Retinal fundus photograph; image size 2212x1659; 45-degree field of view.
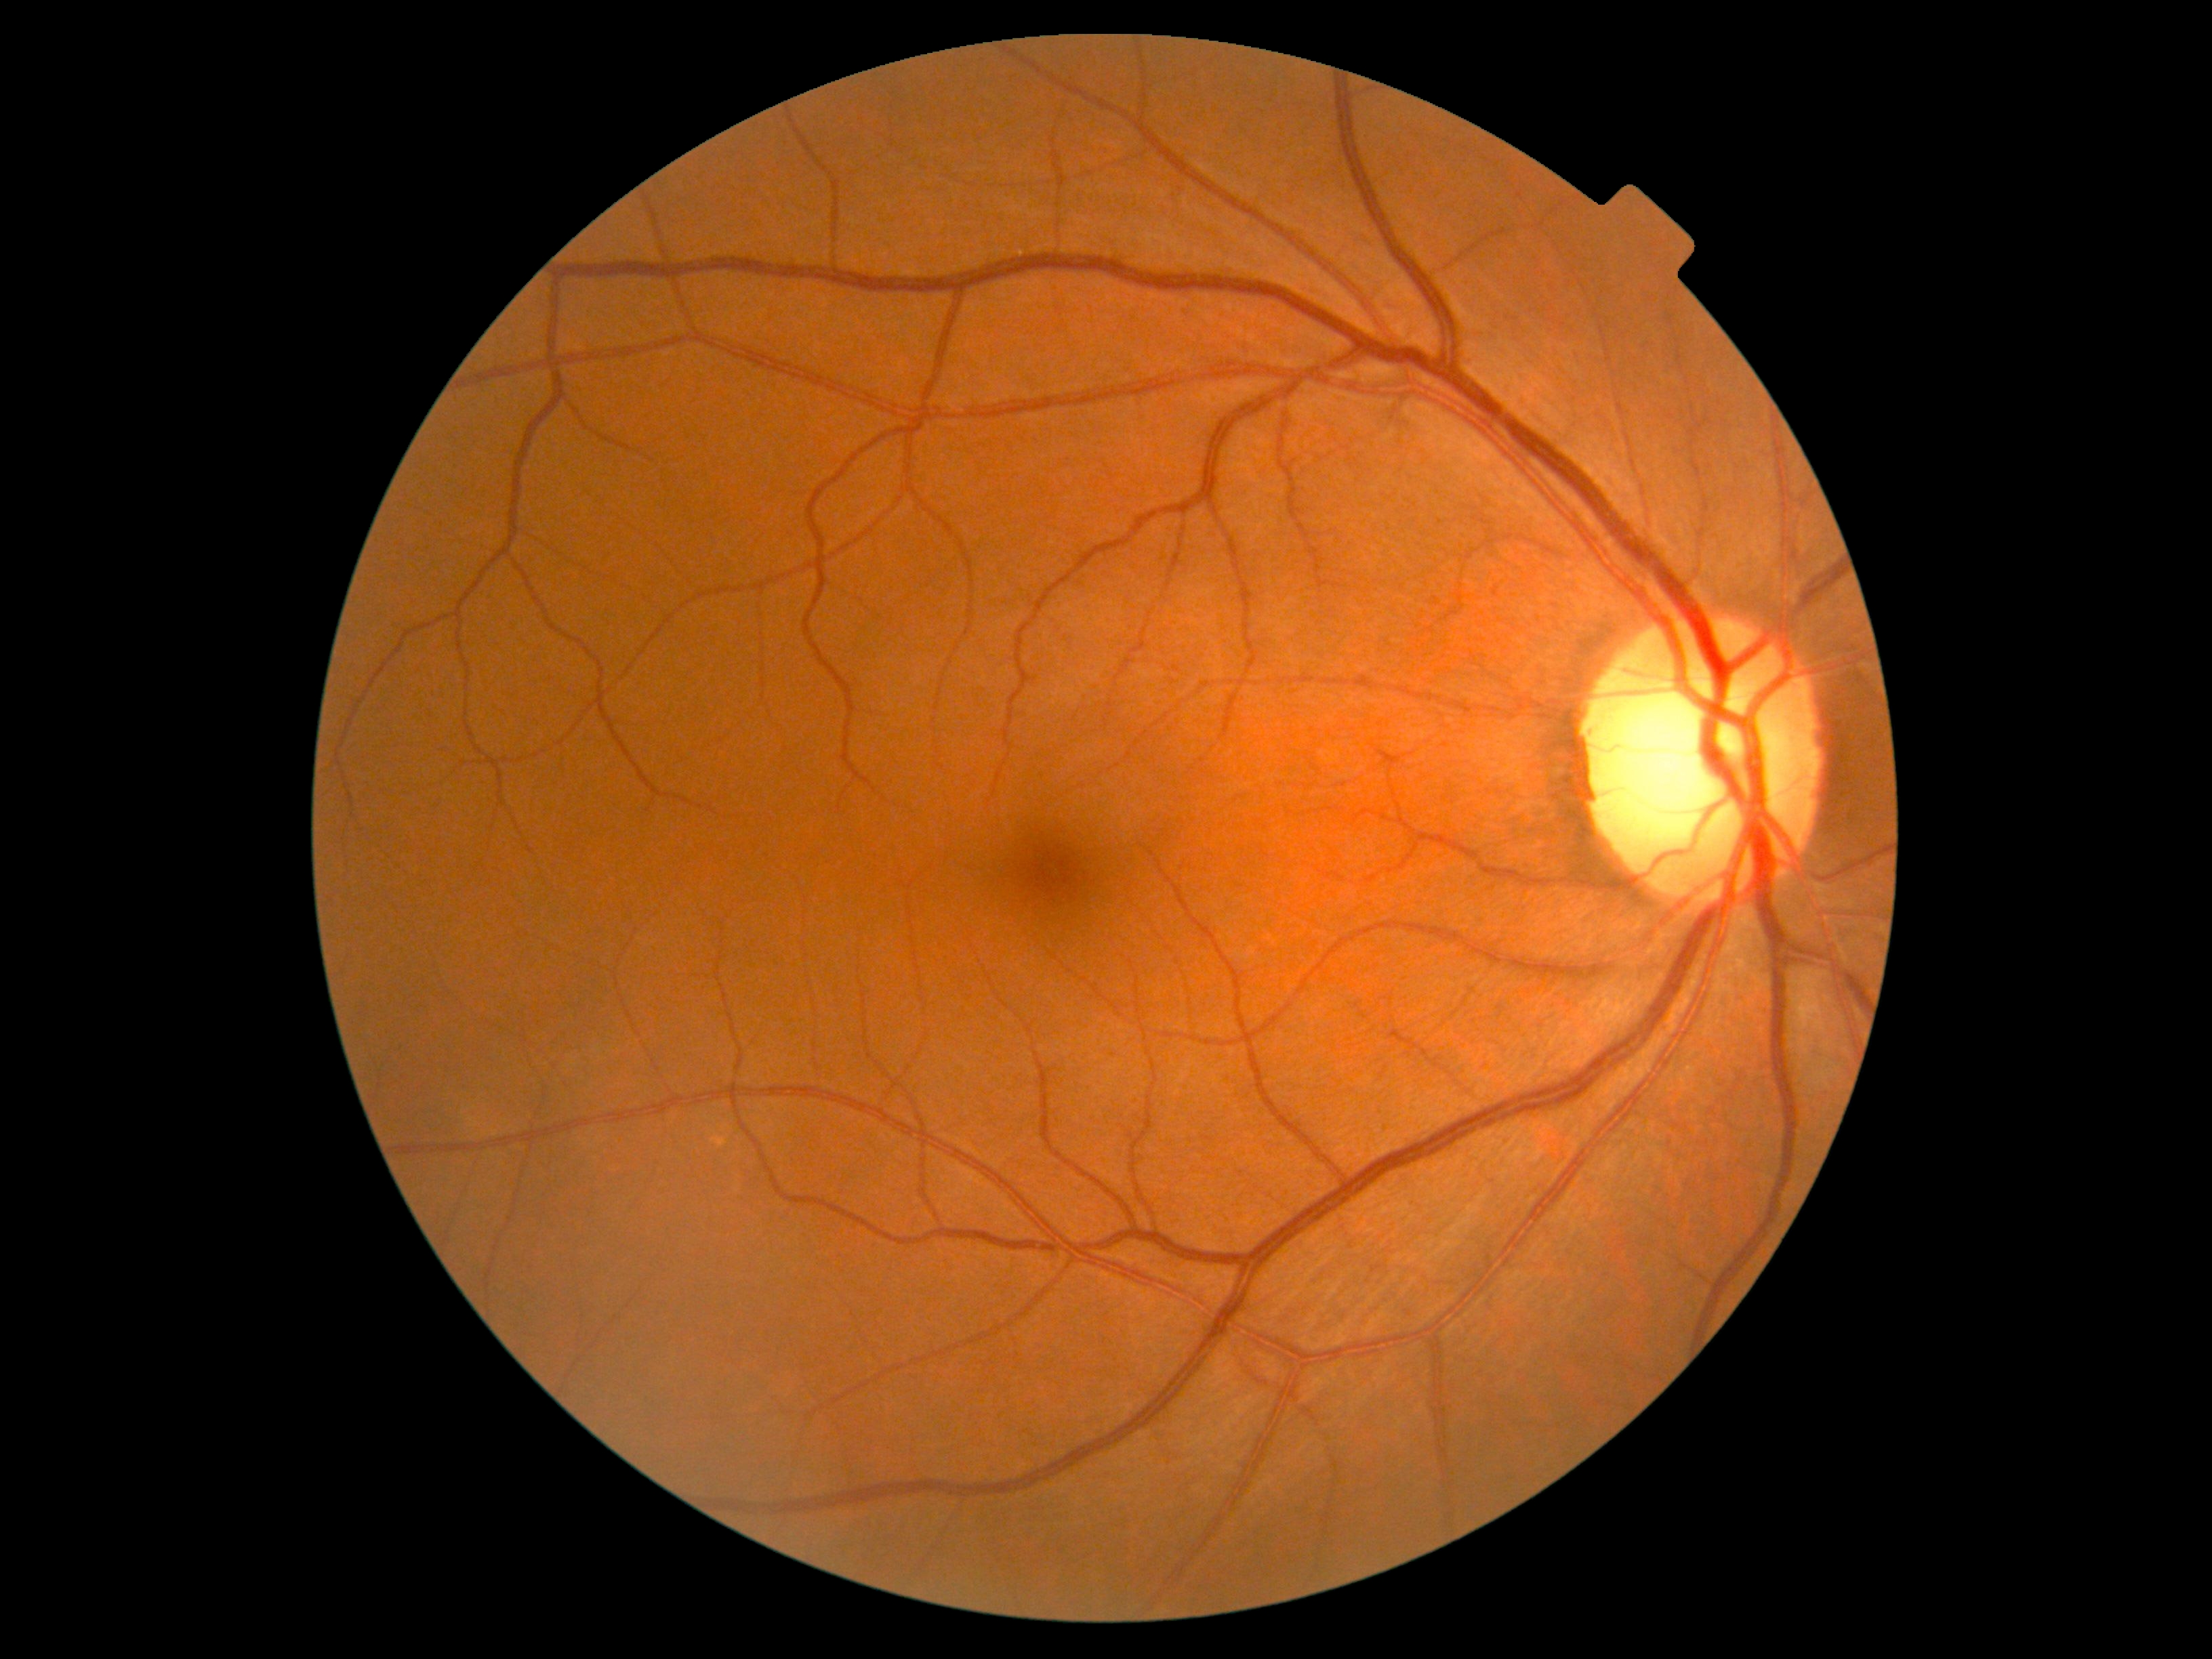
Diabetic retinopathy severity is 0.
No diabetic retinal disease findings.